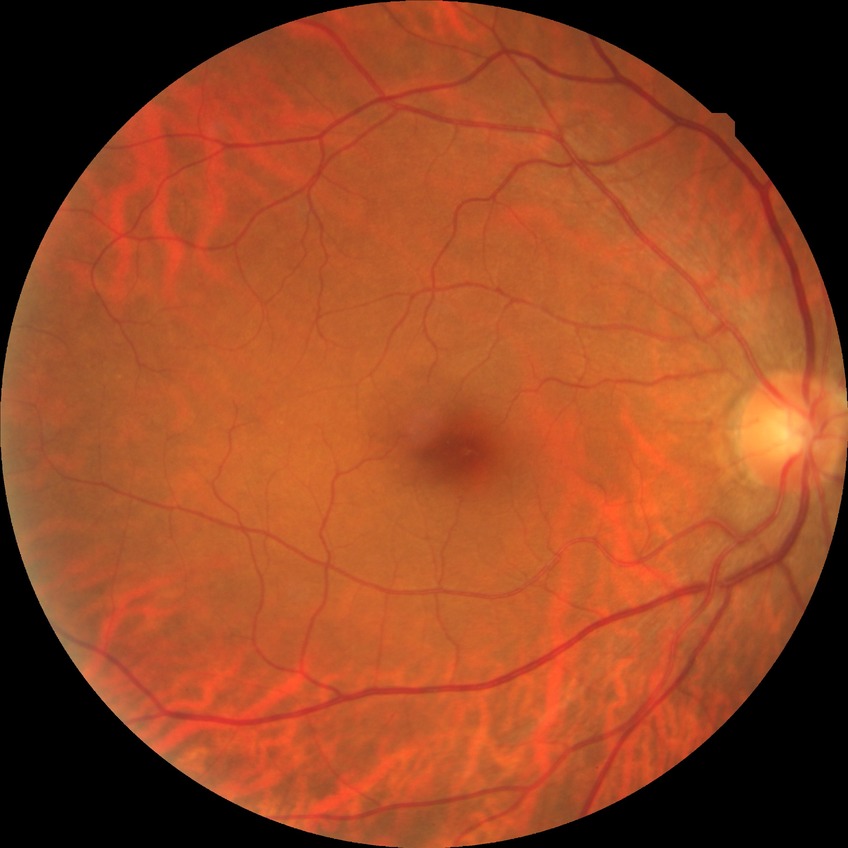
Diabetic retinopathy (DR): no diabetic retinopathy (NDR).